NIDEK AFC-230 fundus camera — 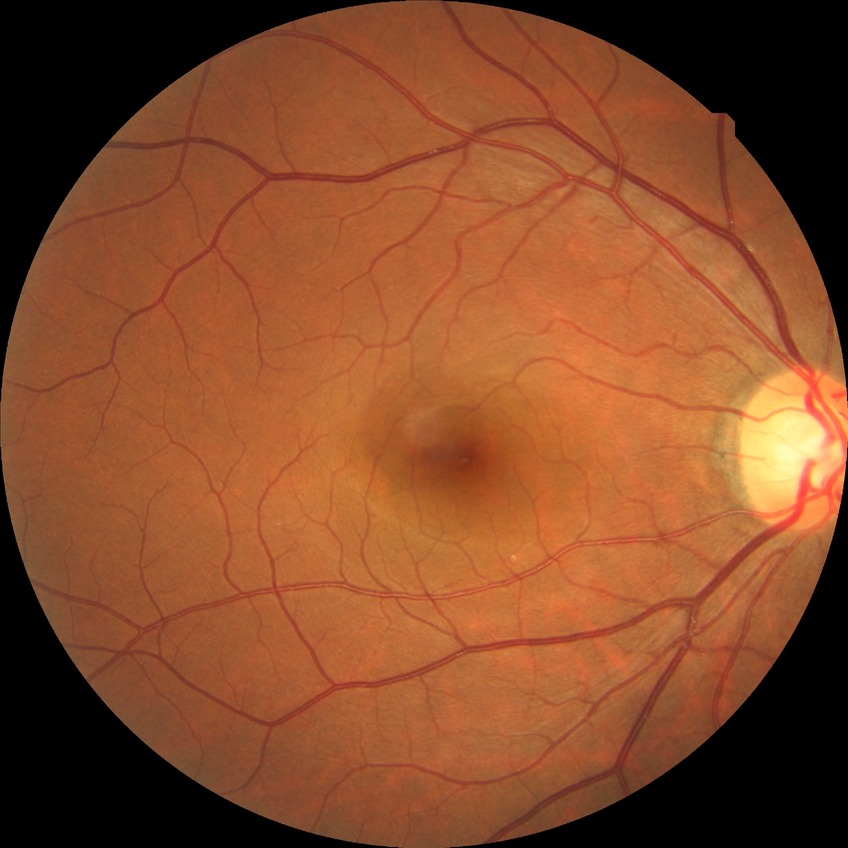

  davis_grade: no diabetic retinopathy